Wide-field fundus photograph of an infant · image size 1240x1240
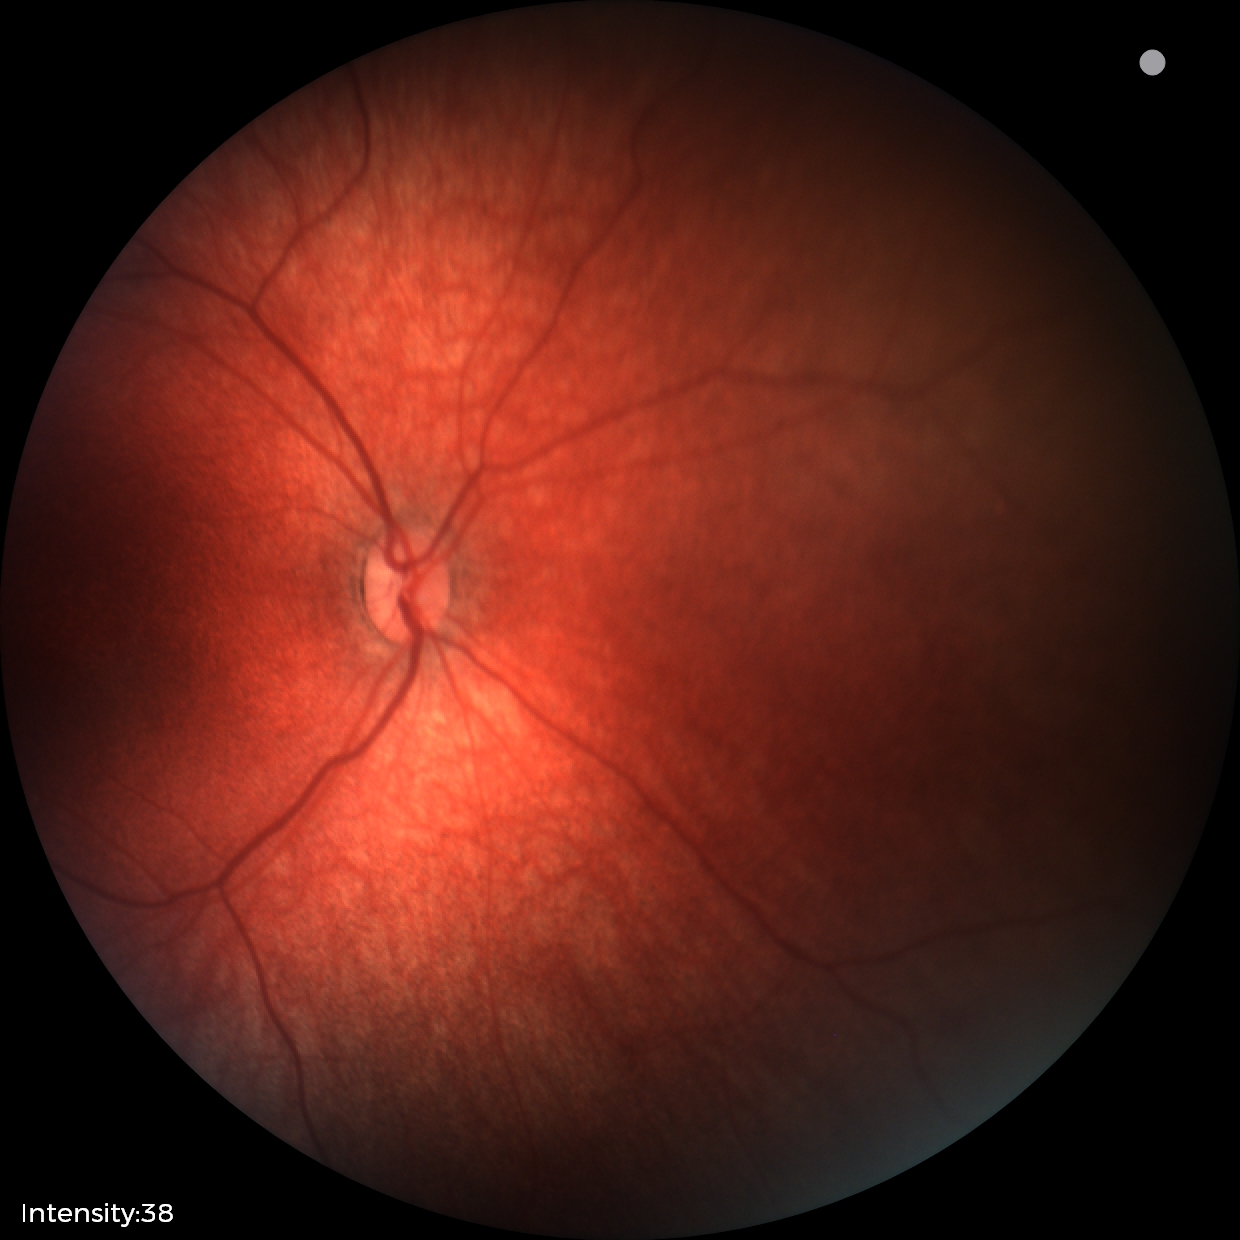 Examination with physiological retinal findings.